Infant wide-field retinal image. Image size 640x480. Captured with the Clarity RetCam 3 (130° field of view): 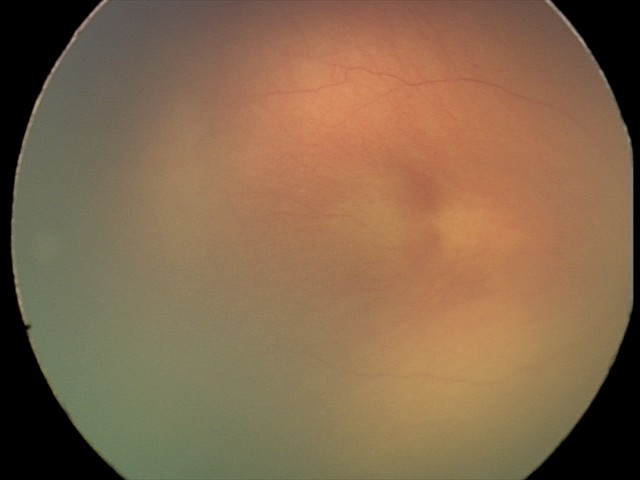

Finding: ROP stage 0; plus disease: absent — posterior pole vessels without abnormal dilation or tortuosity.